Without pupil dilation, 848 x 848 pixels, acquired with a NIDEK AFC-230, fundus photo: 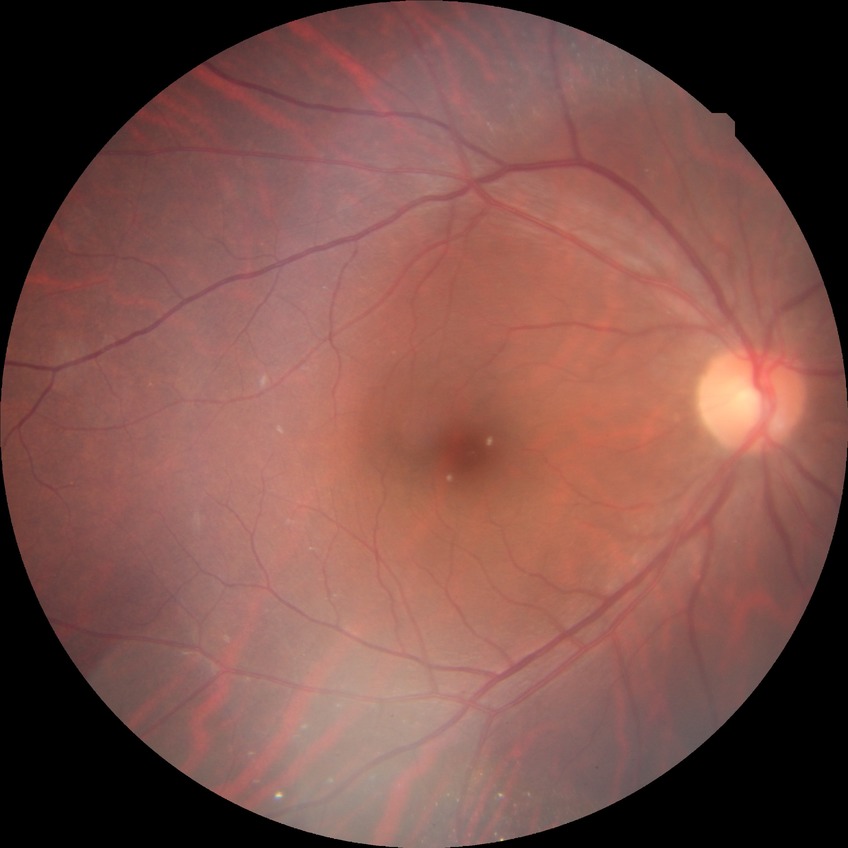 Diabetic retinopathy (DR) is NDR (no diabetic retinopathy).